Wide-field fundus image from infant ROP screening
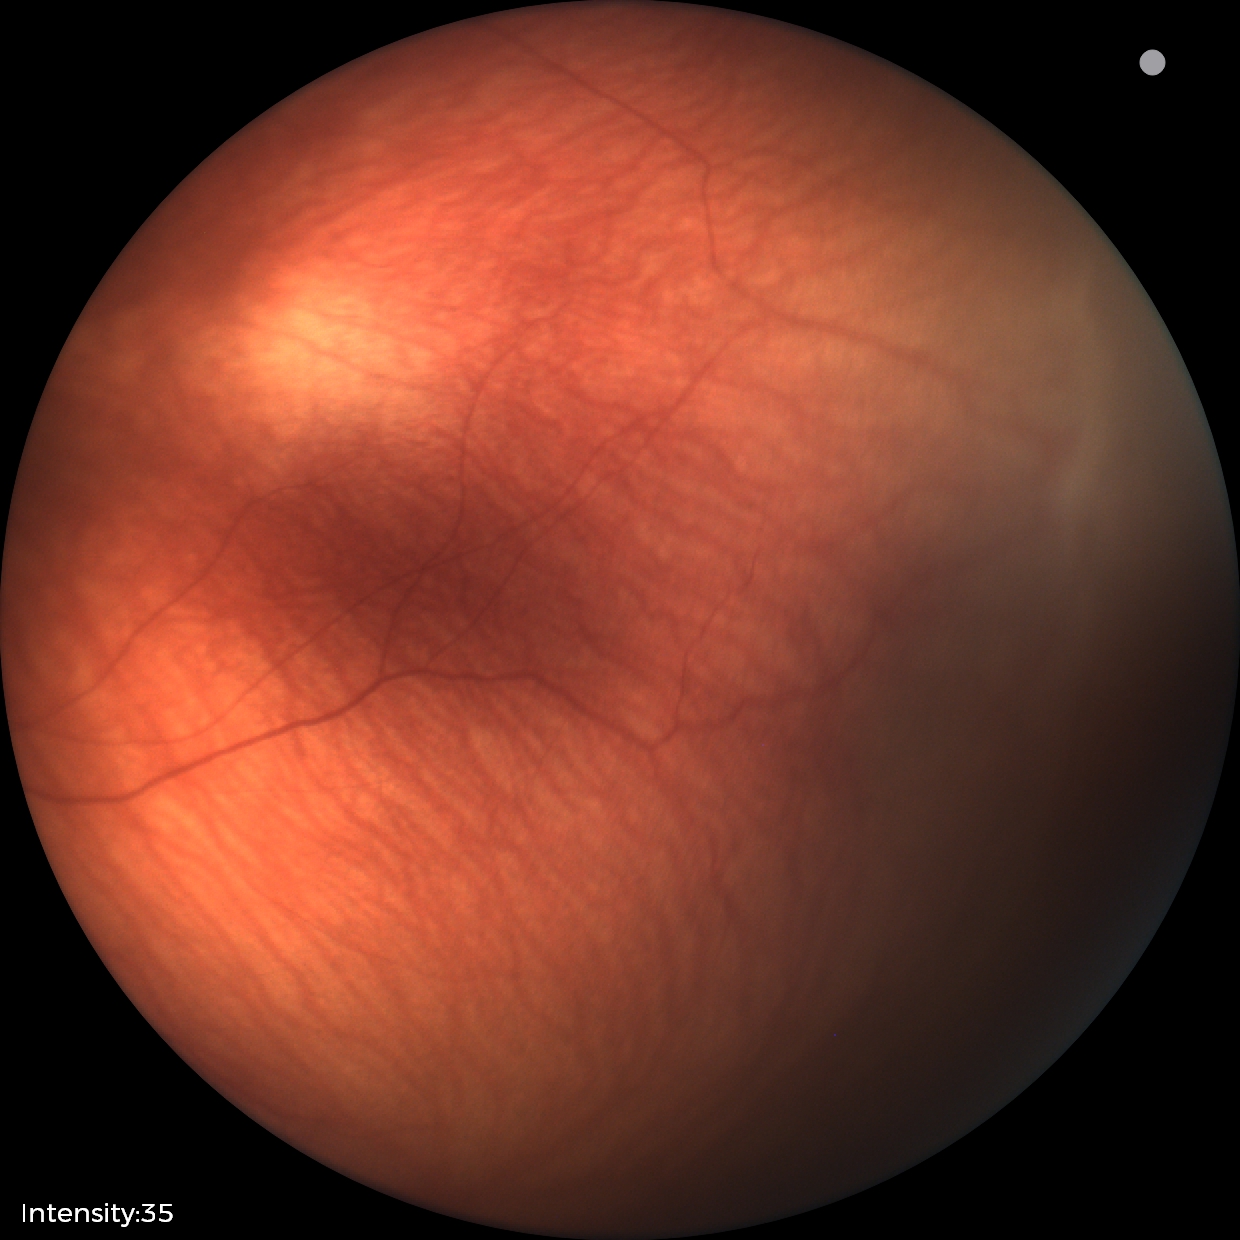
Examination diagnosed as retinopathy of prematurity (ROP) stage 2.